848 x 848 pixels; nonmydriatic fundus photograph; graded on the modified Davis scale.
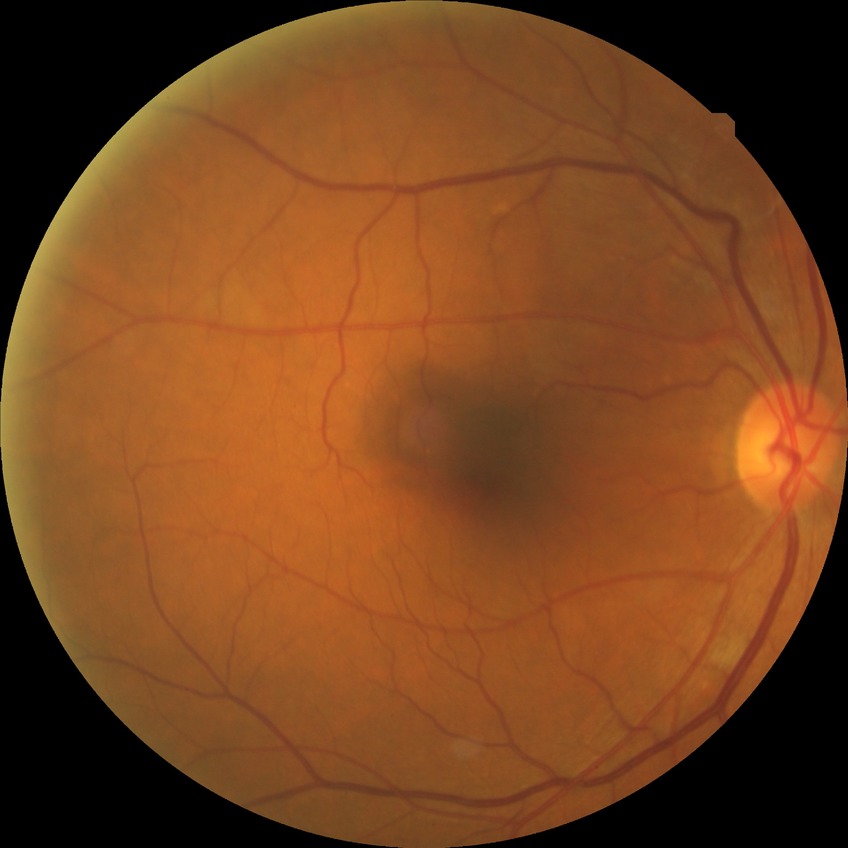

Davis stage: NDR. No DR findings.